45° FOV. Nonmydriatic. NIDEK AFC-230 fundus camera:
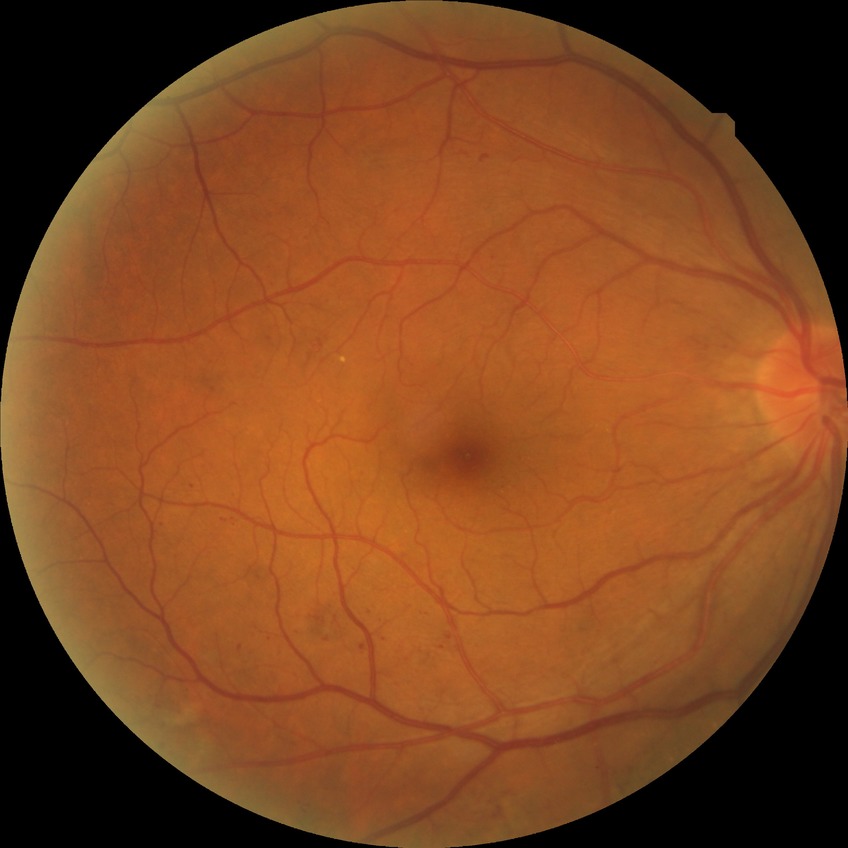

diabetic retinopathy grade@simple diabetic retinopathy.